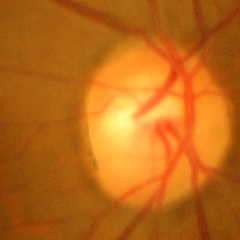
Findings consistent with glaucoma.
Advanced glaucomatous optic neuropathy.